1440x1080 · pediatric retinal photograph (wide-field): 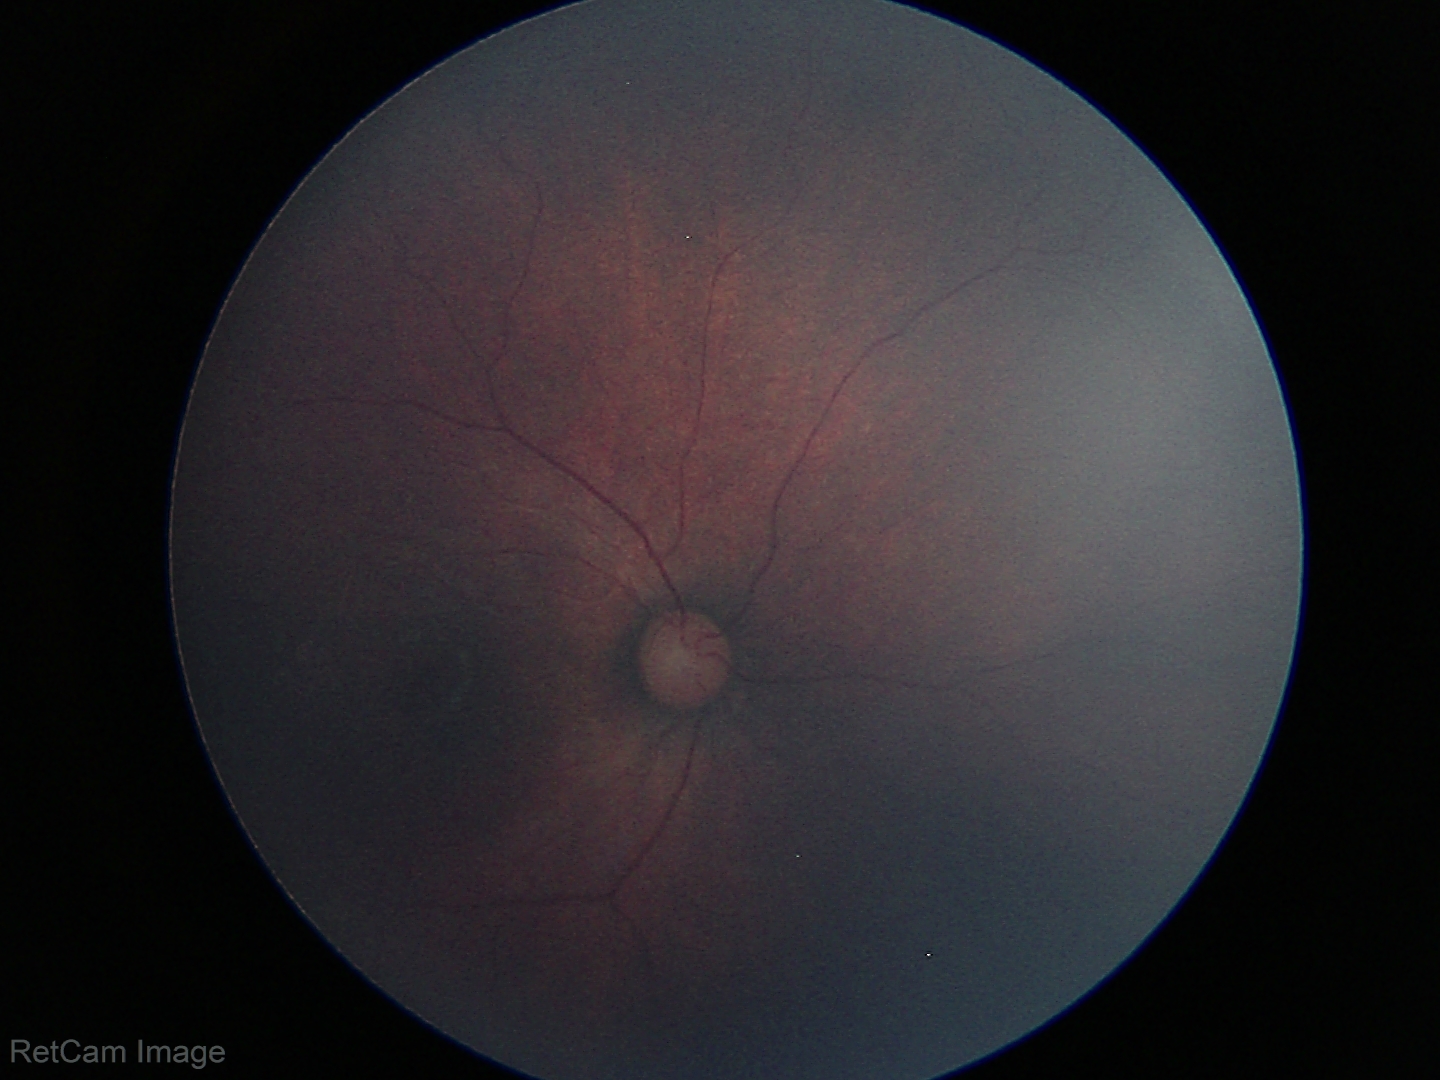

Screening diagnosis: normal fundus examination.